45-degree field of view.
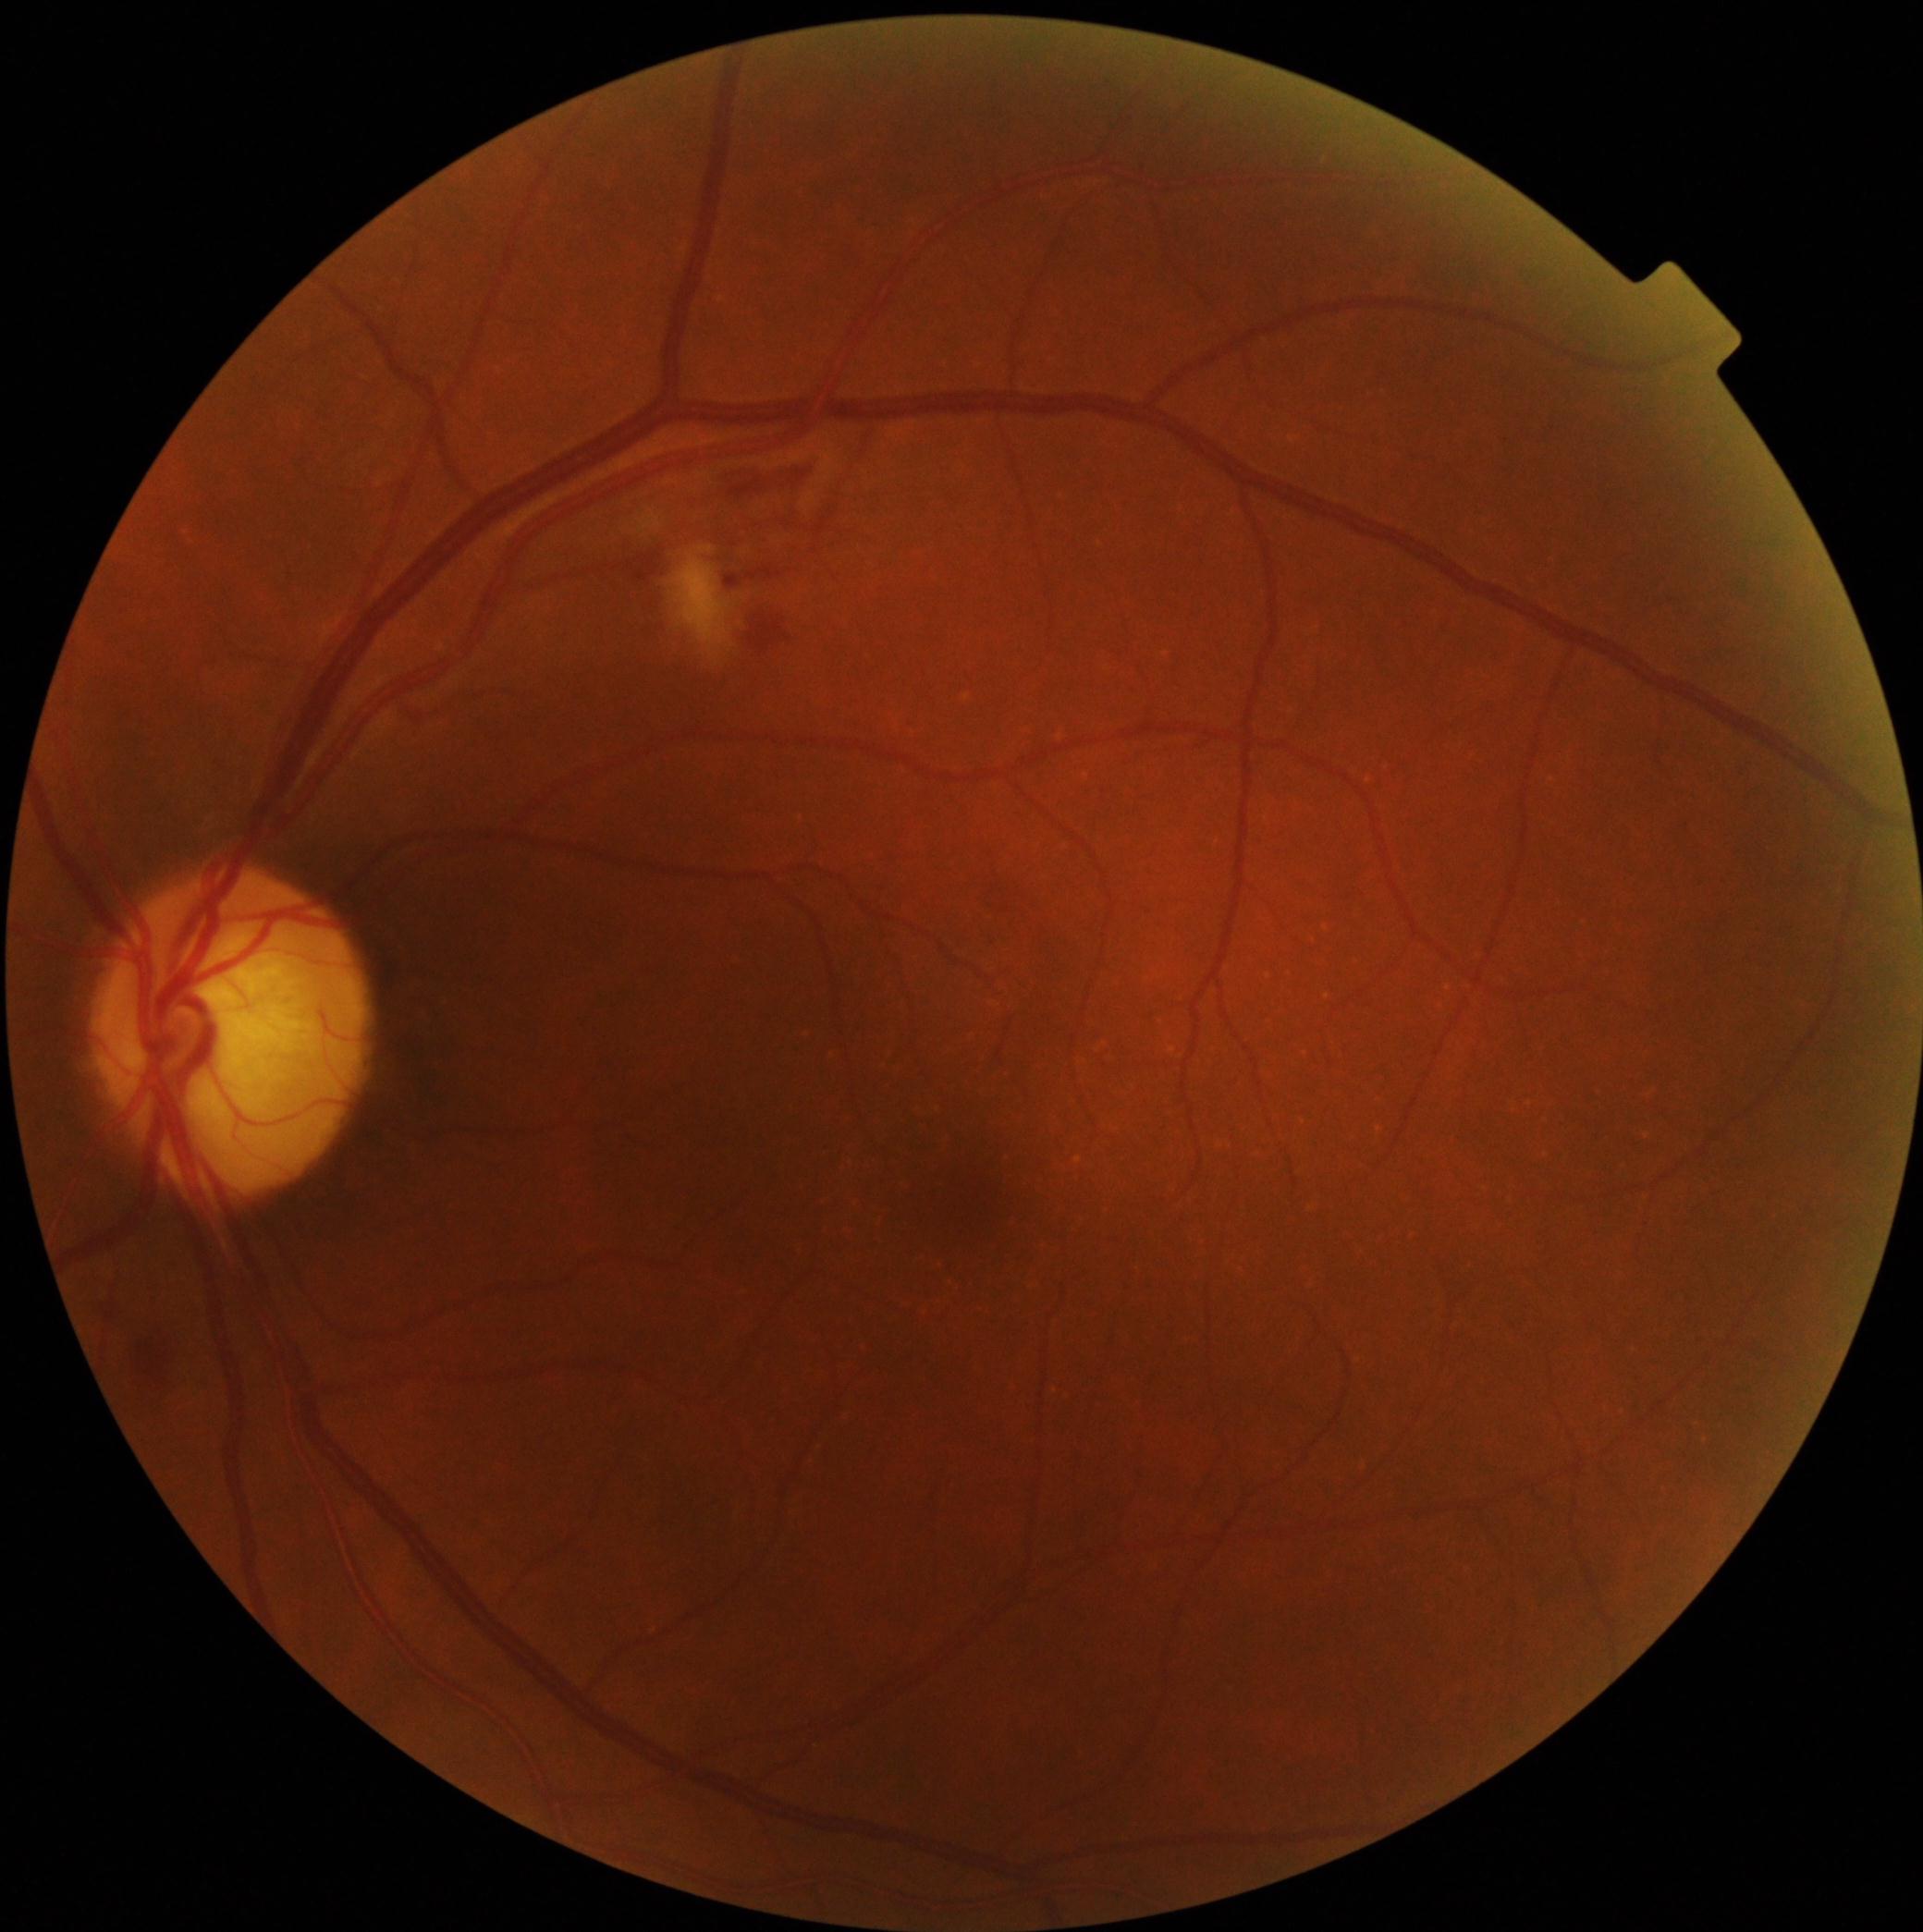
DR stage is 2/4. DR class: non-proliferative diabetic retinopathy.